CFP
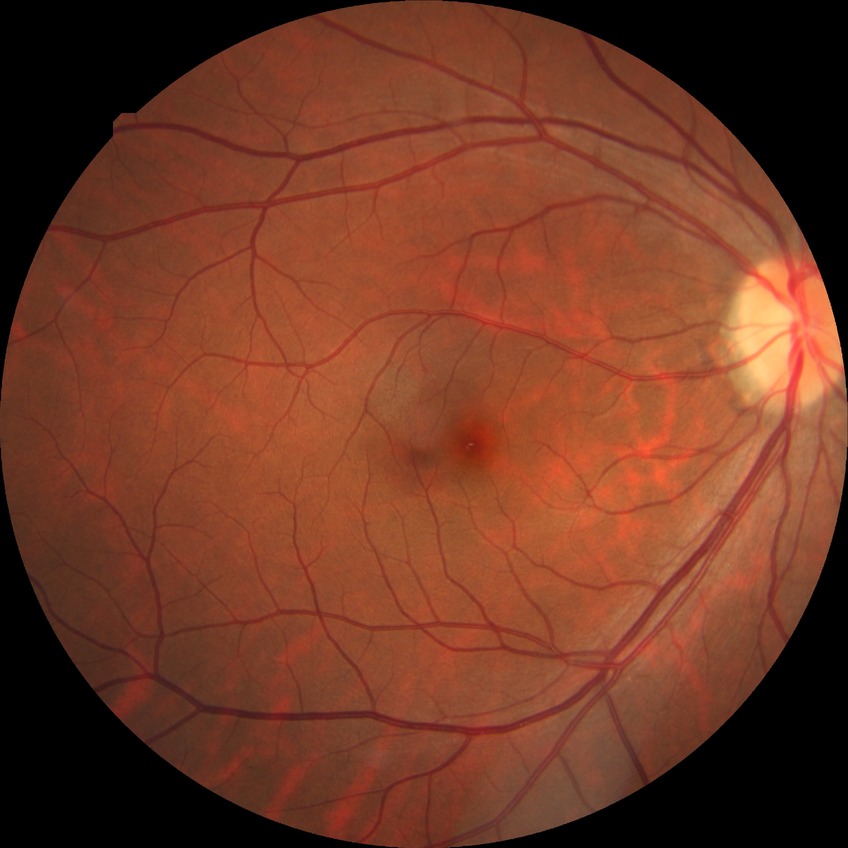
diabetic retinopathy (DR): NDR (no diabetic retinopathy).